Fundus photo:
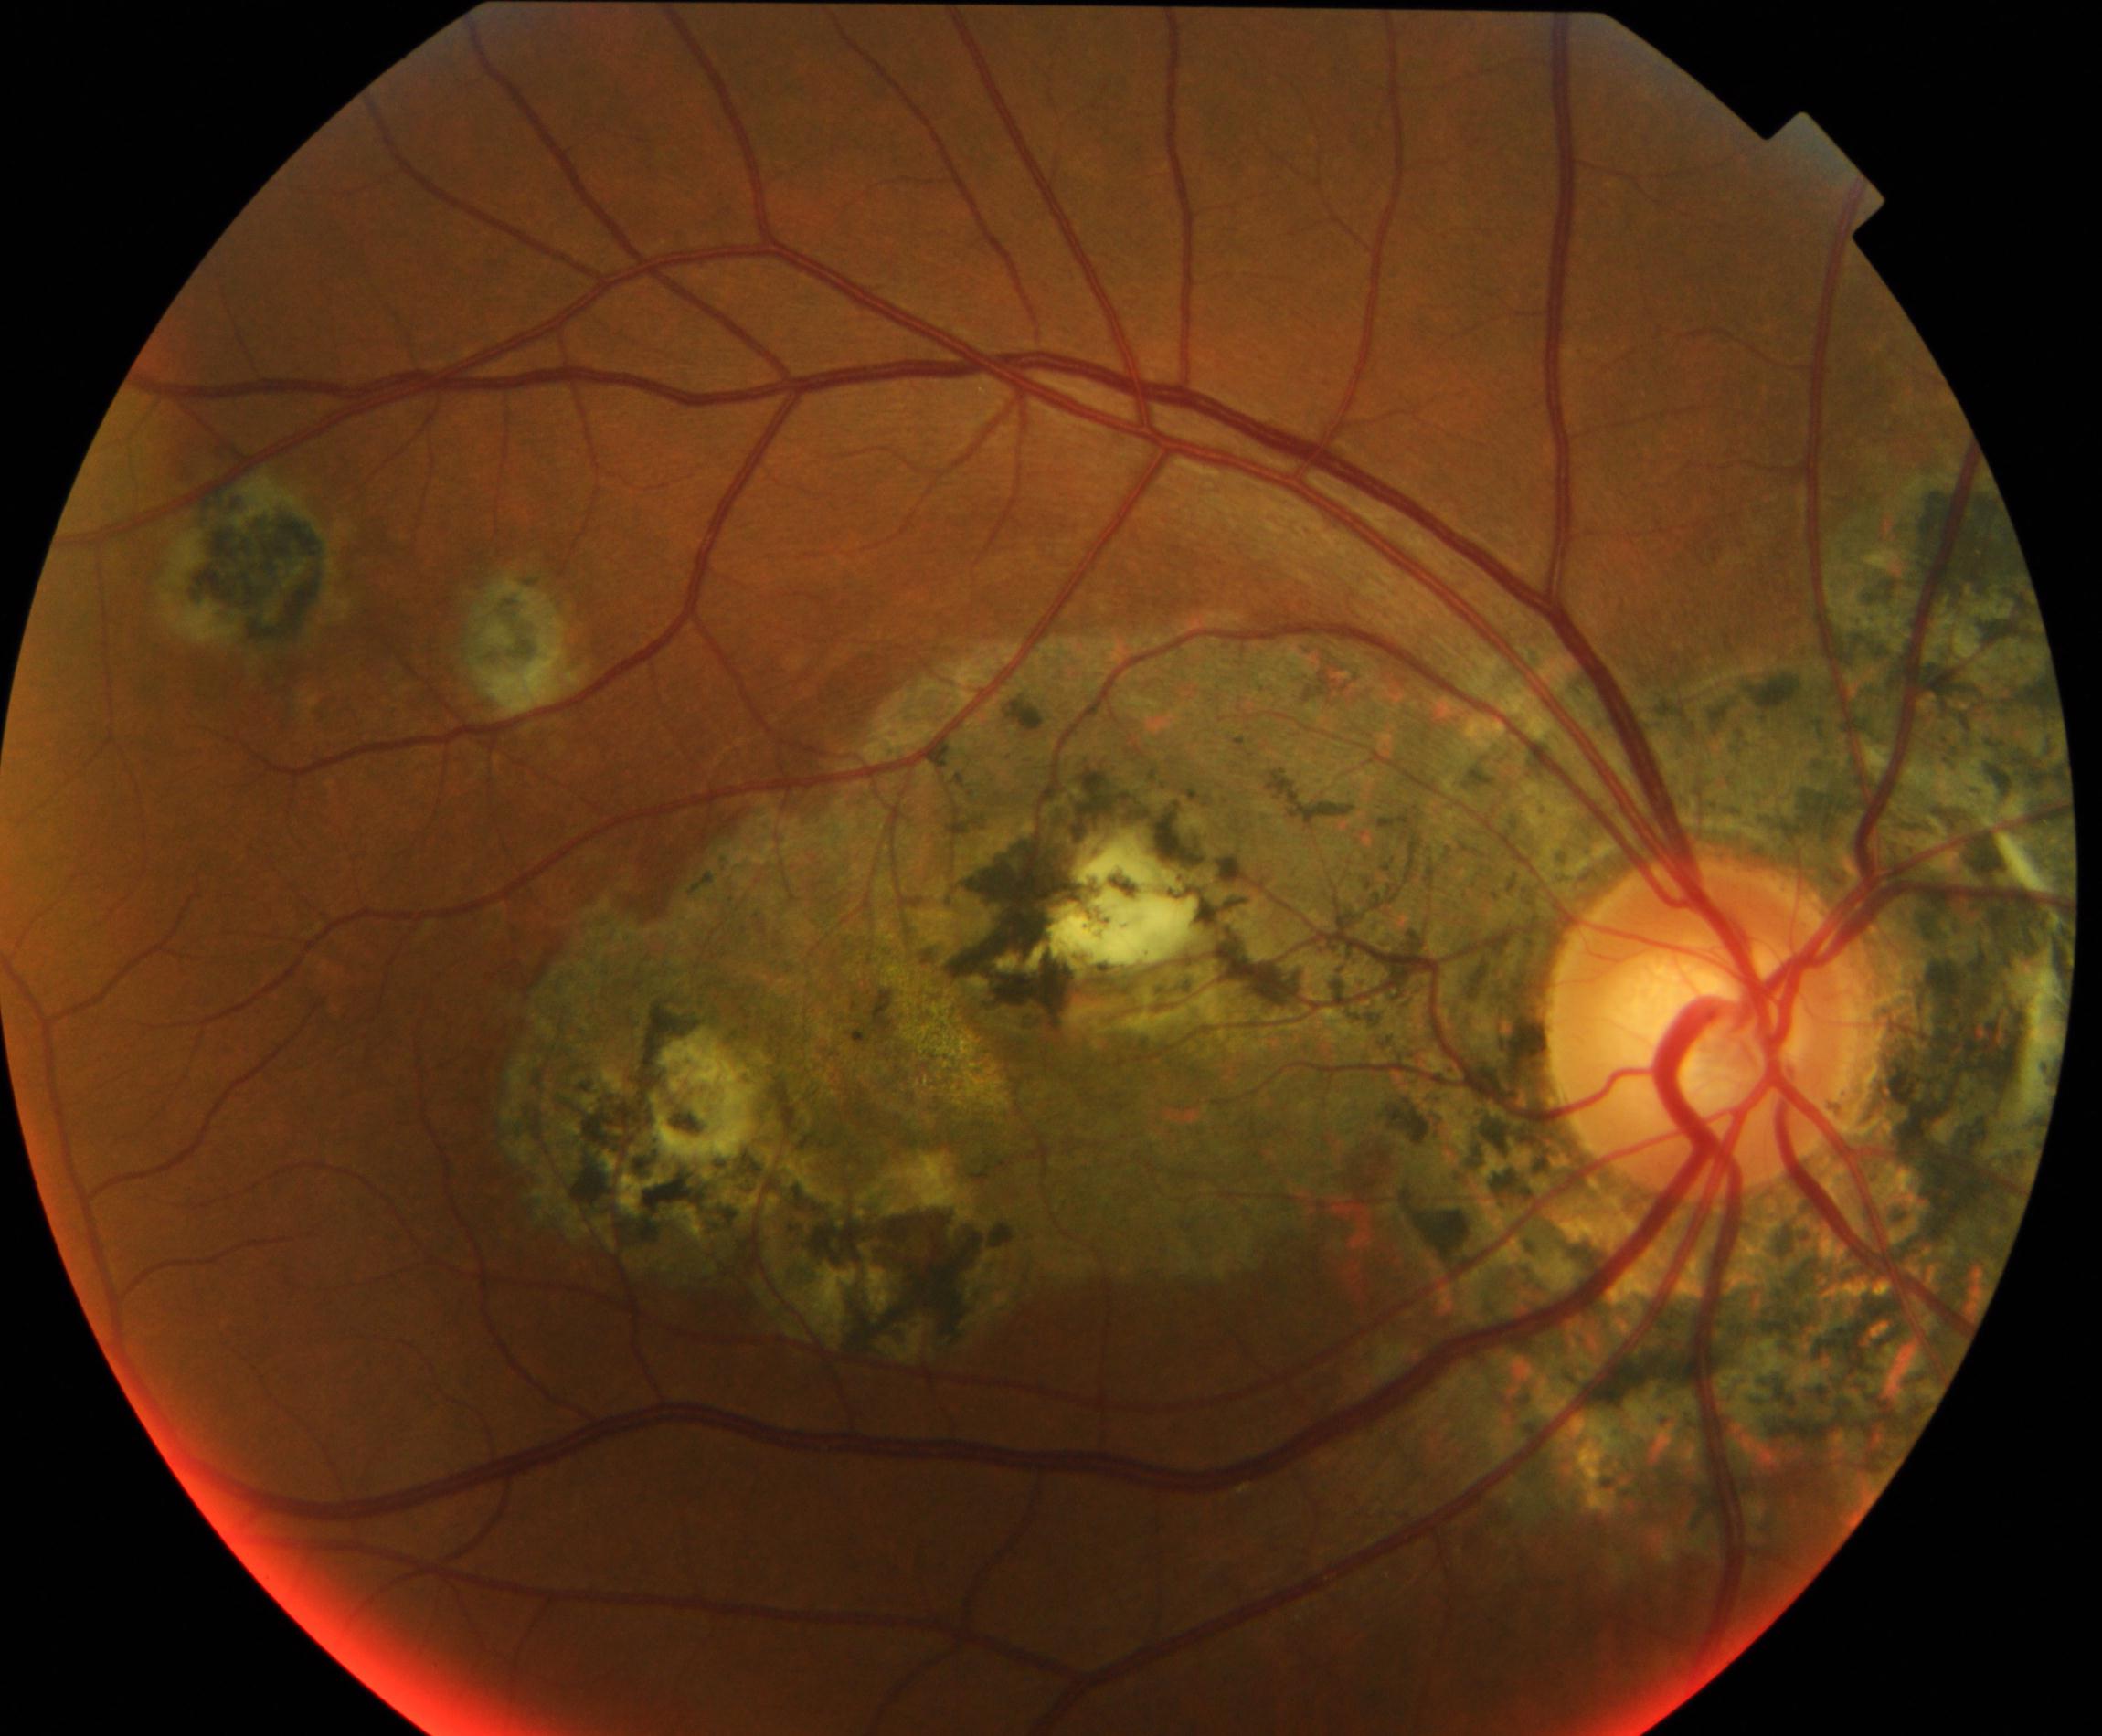

Impression: chorioretinal atrophy or coloboma.